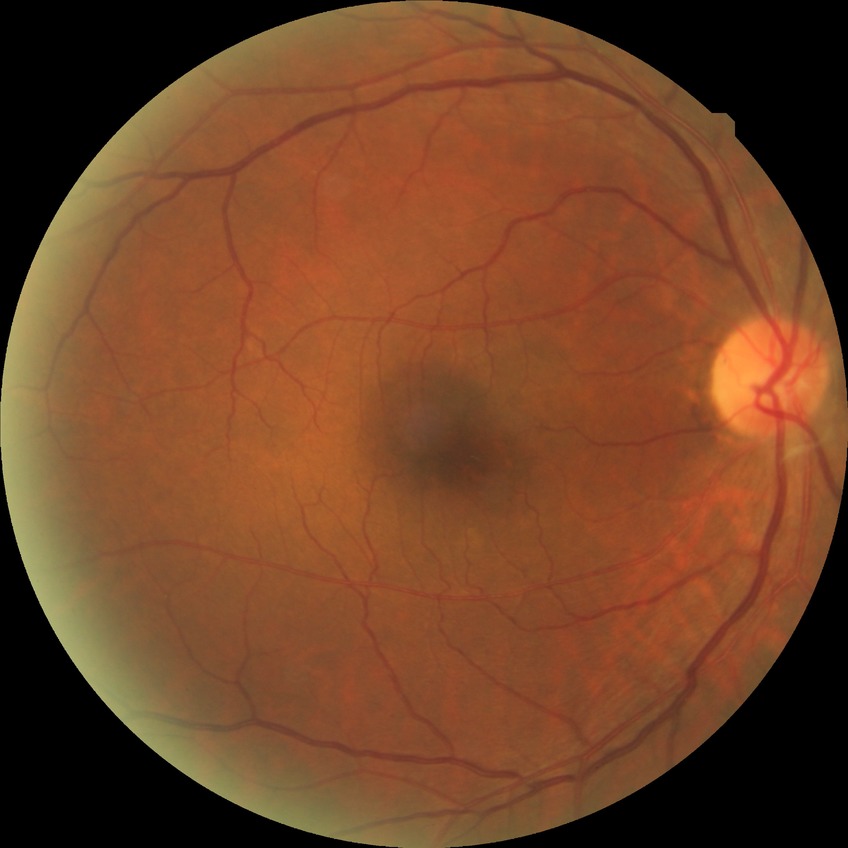
Diabetic retinopathy (DR): no diabetic retinopathy (NDR).